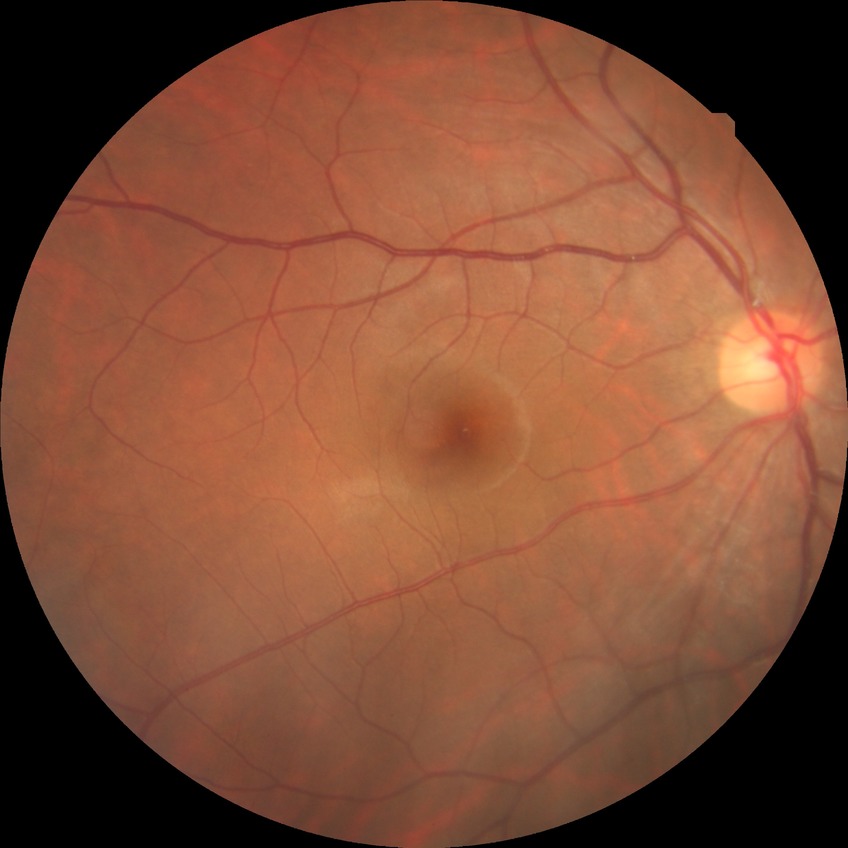

Diabetic retinopathy (DR) is NDR (no diabetic retinopathy).